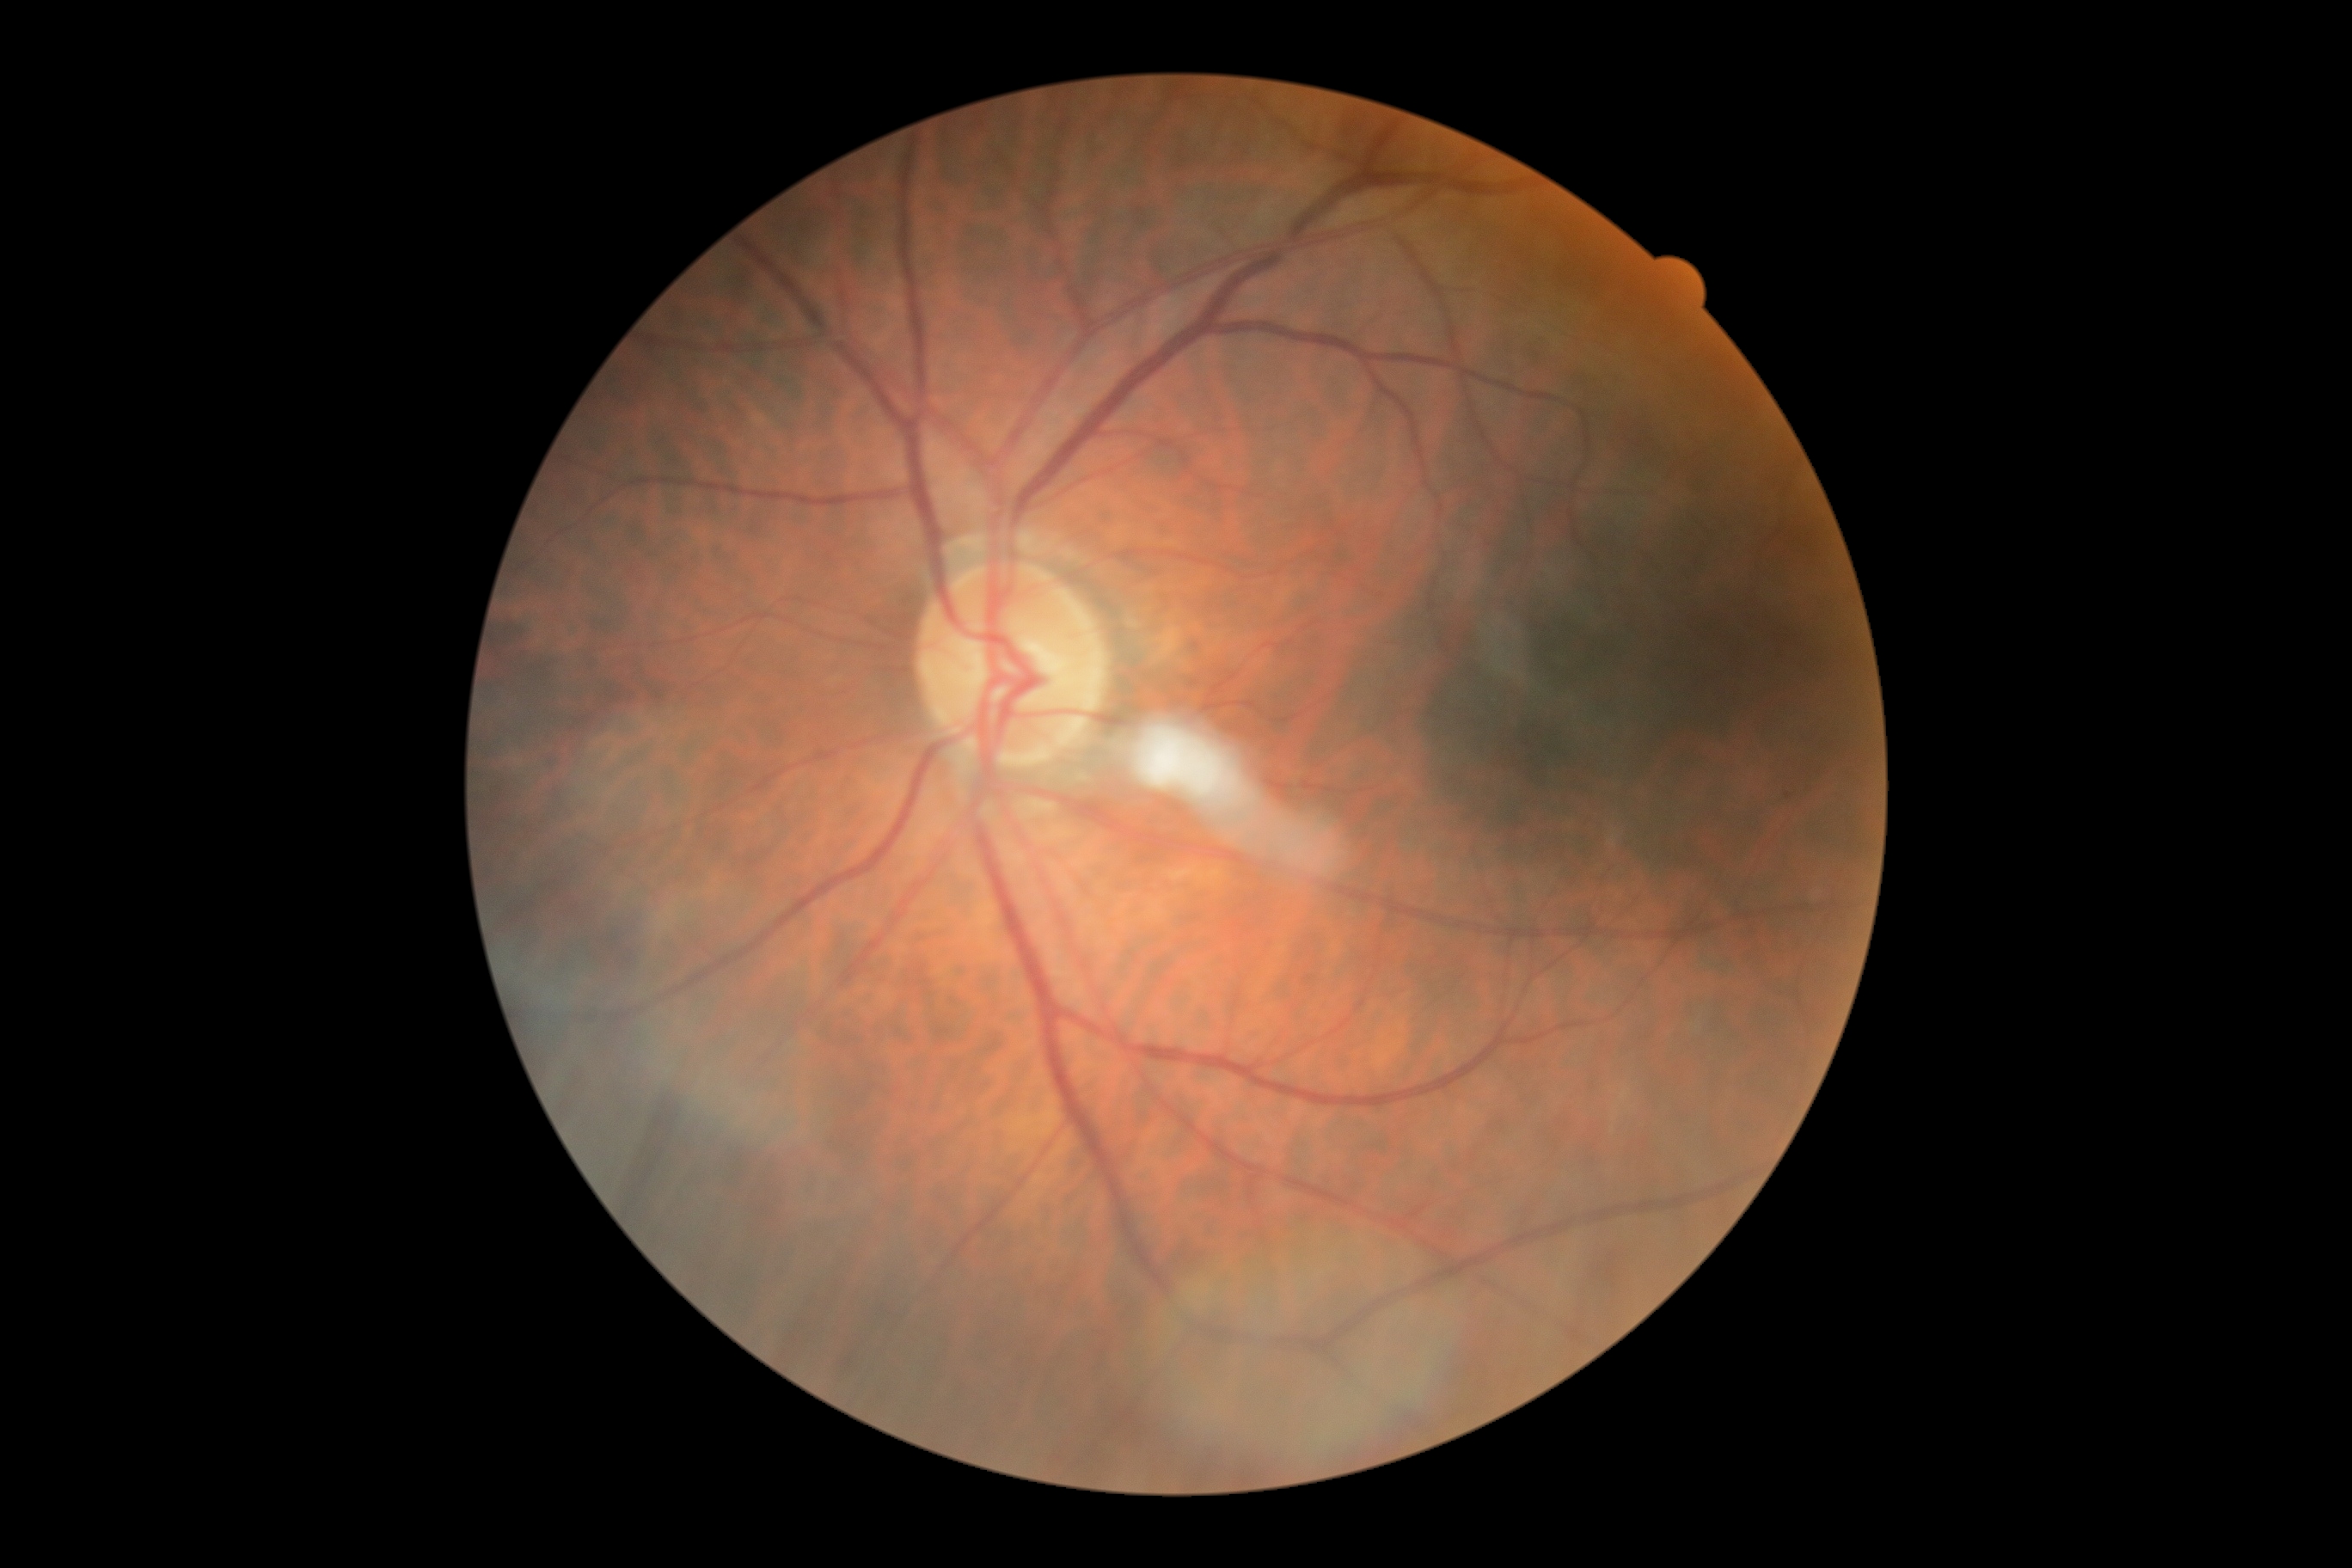 retinopathy grade: 1; DR class: non-proliferative diabetic retinopathy.